Color fundus image, modified Davis classification.
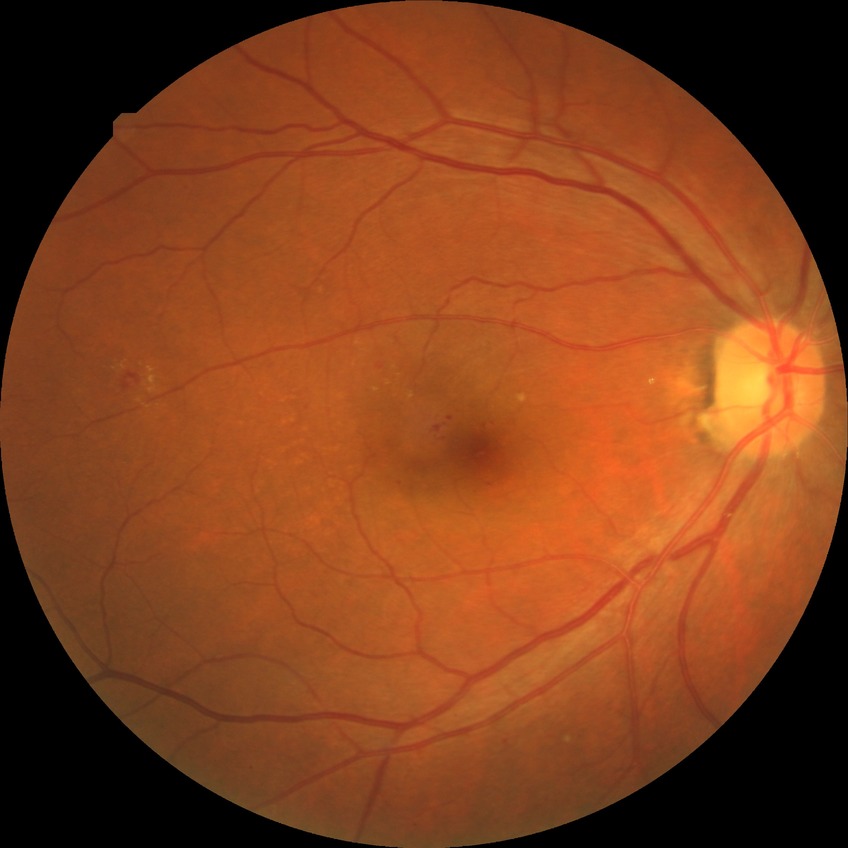

Davis grade: SDR.